Acquired on the Clarity RetCam 3. Pediatric wide-field fundus photograph — 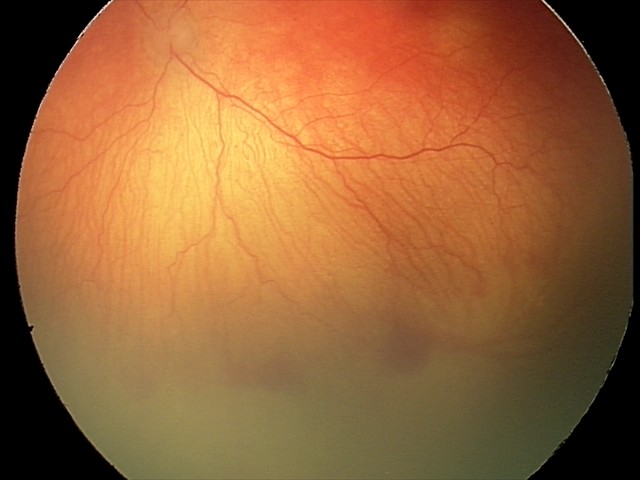
Q: What is the screening diagnosis?
A: aggressive ROP (A-ROP)
Q: Plus disease status?
A: plus disease